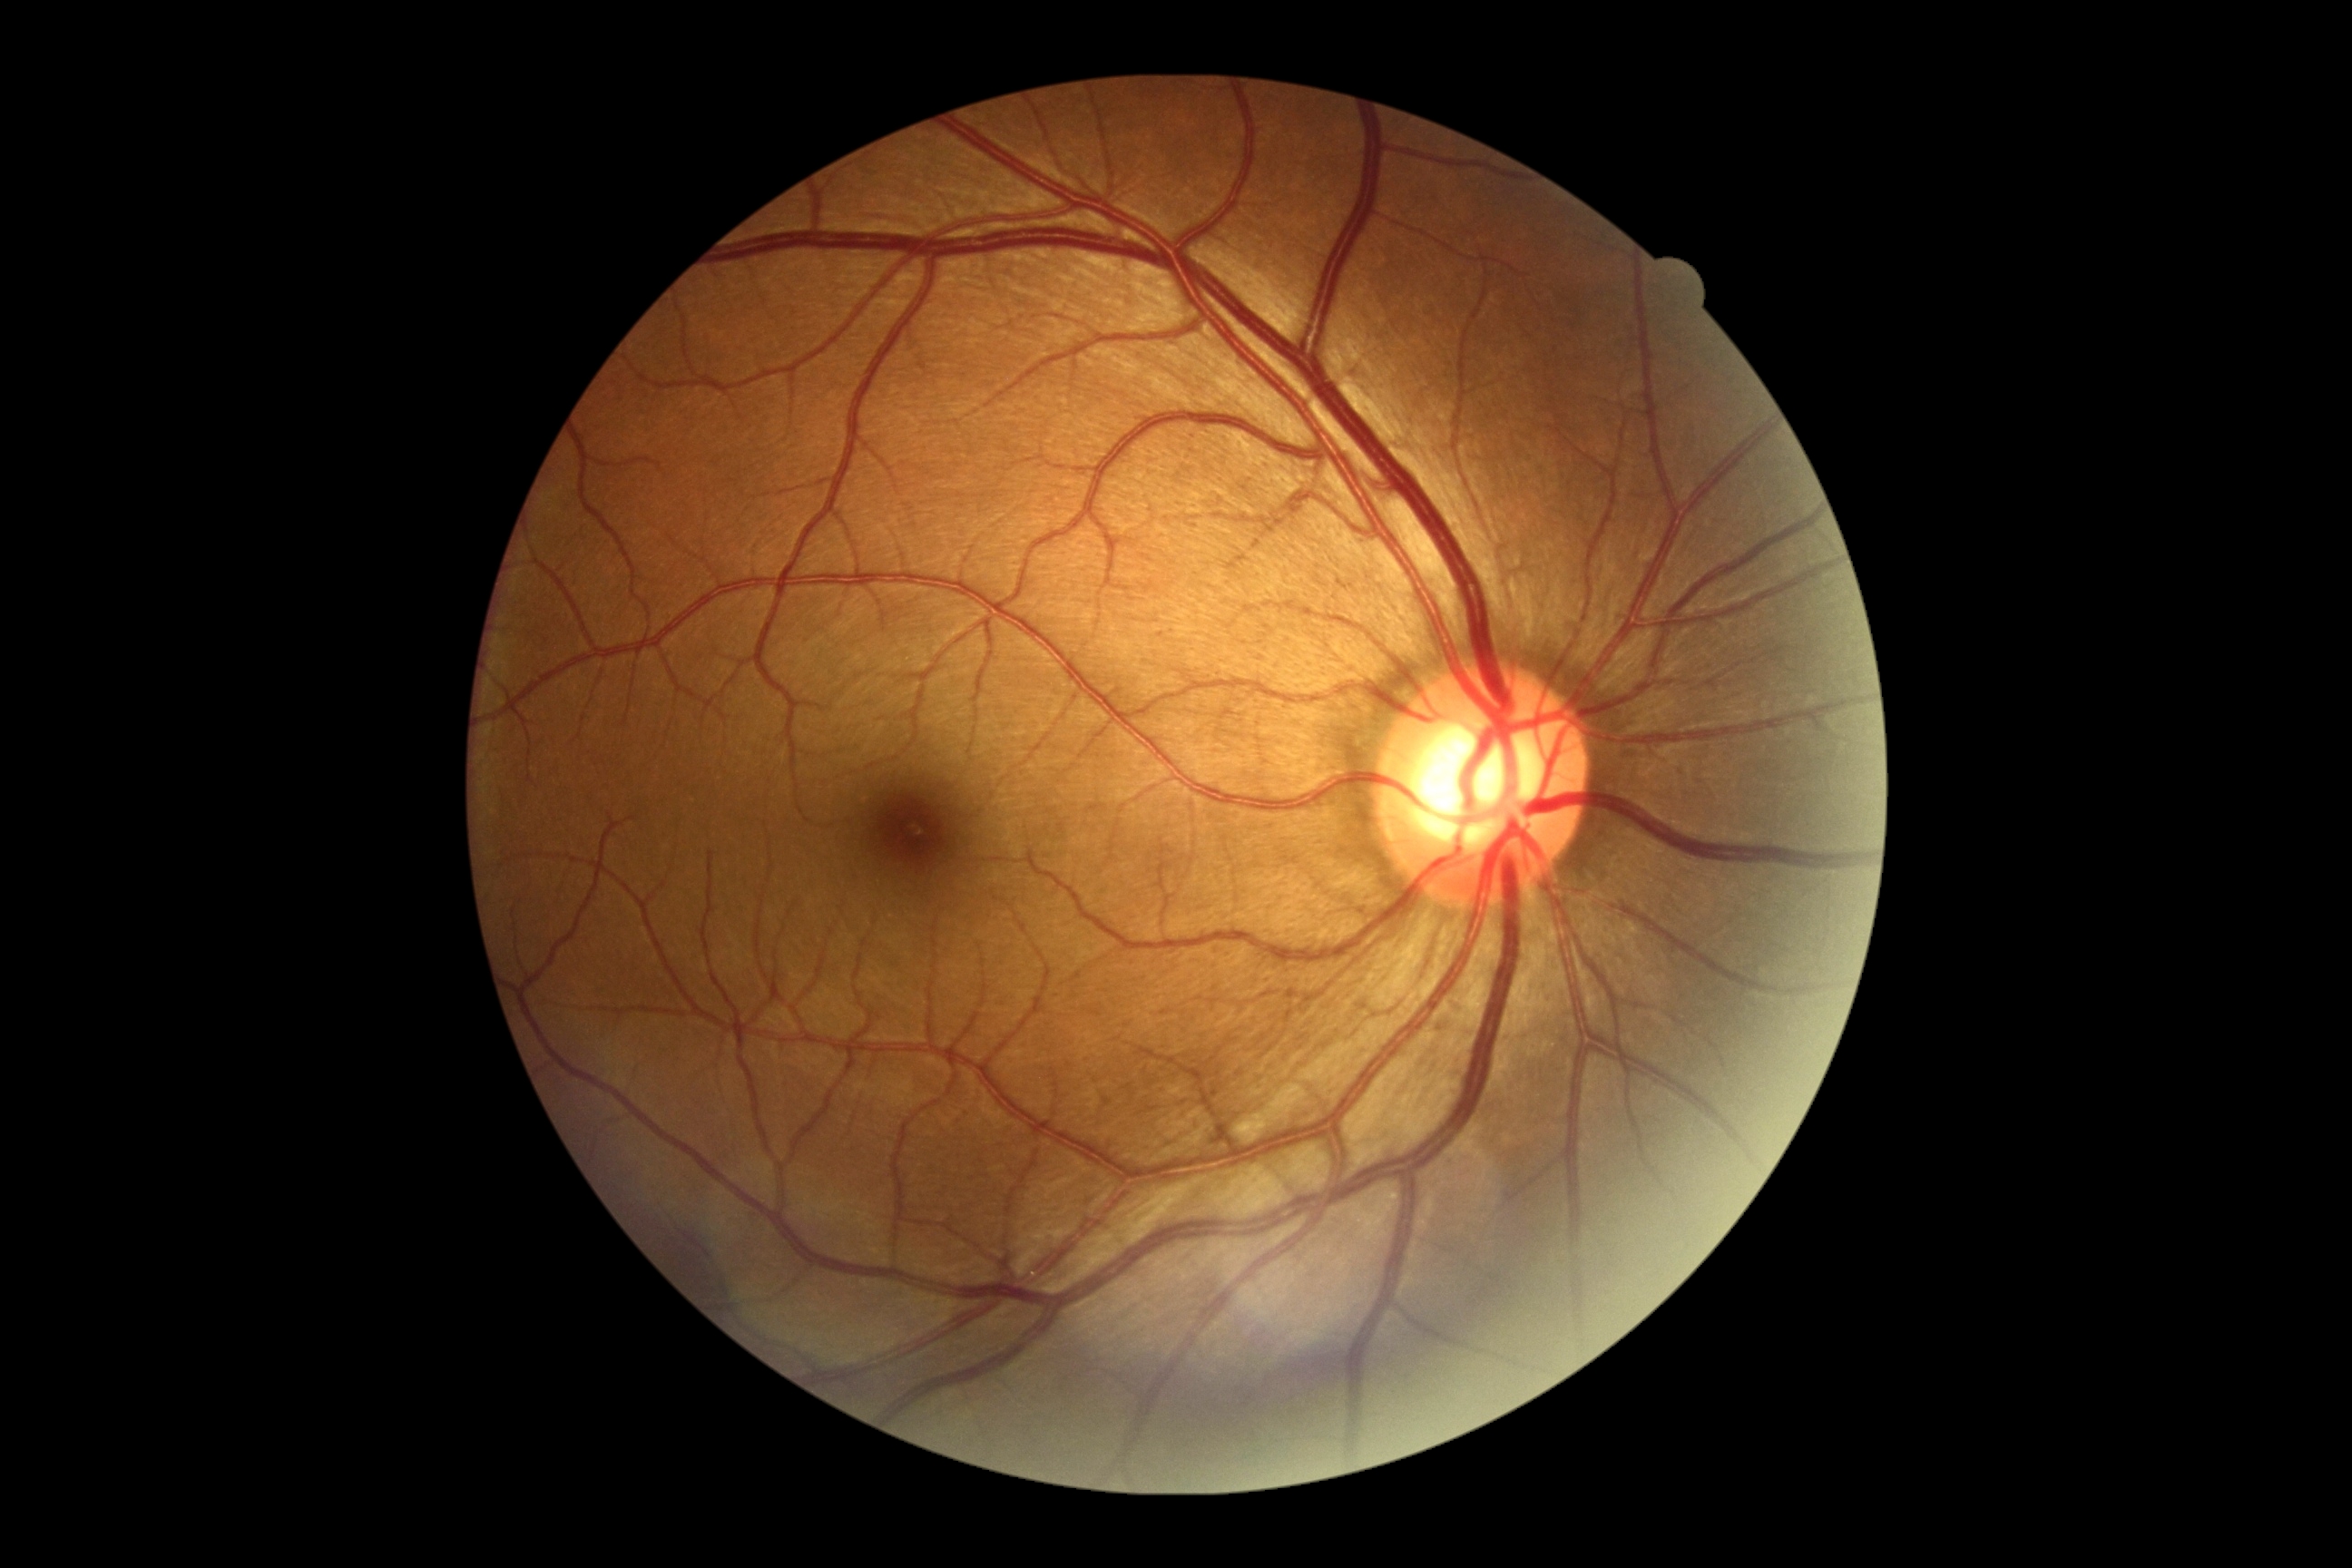
Diabetic retinopathy: no apparent diabetic retinopathy (grade 0).